45° field of view. CFP
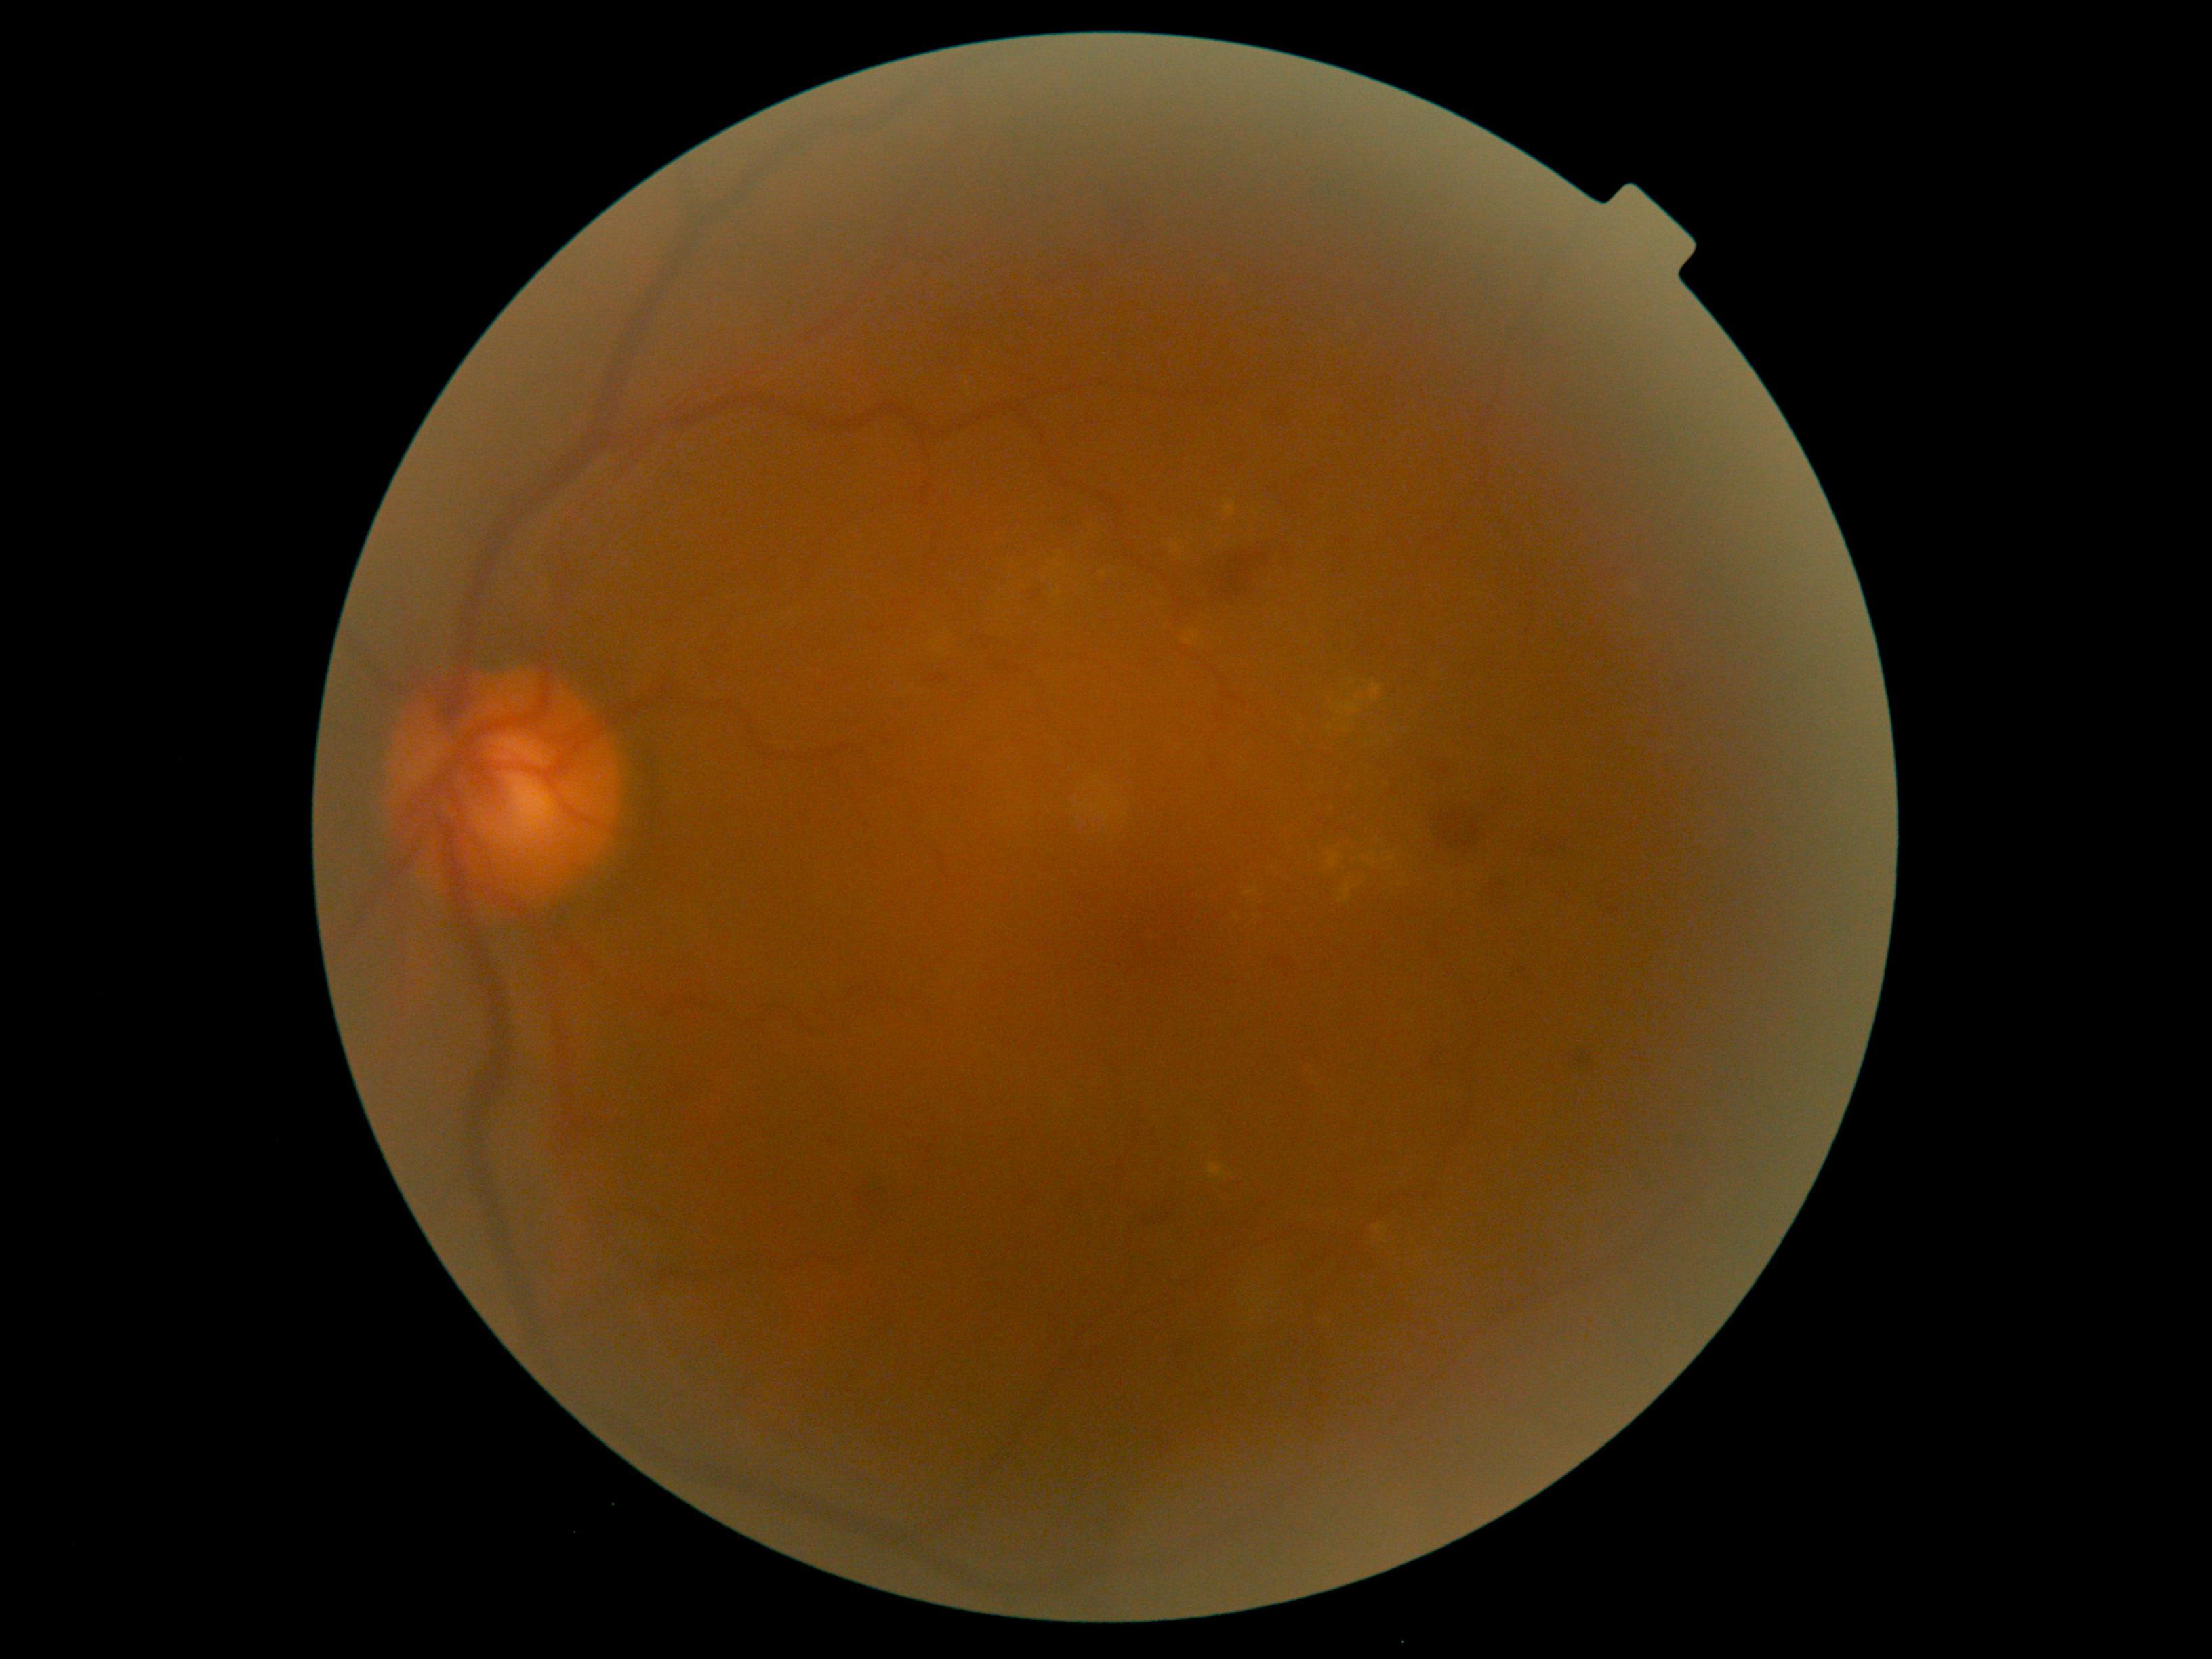
diabetic retinopathy (DR) = moderate NPDR (grade 2).